NIDEK AFC-230 fundus camera, CFP
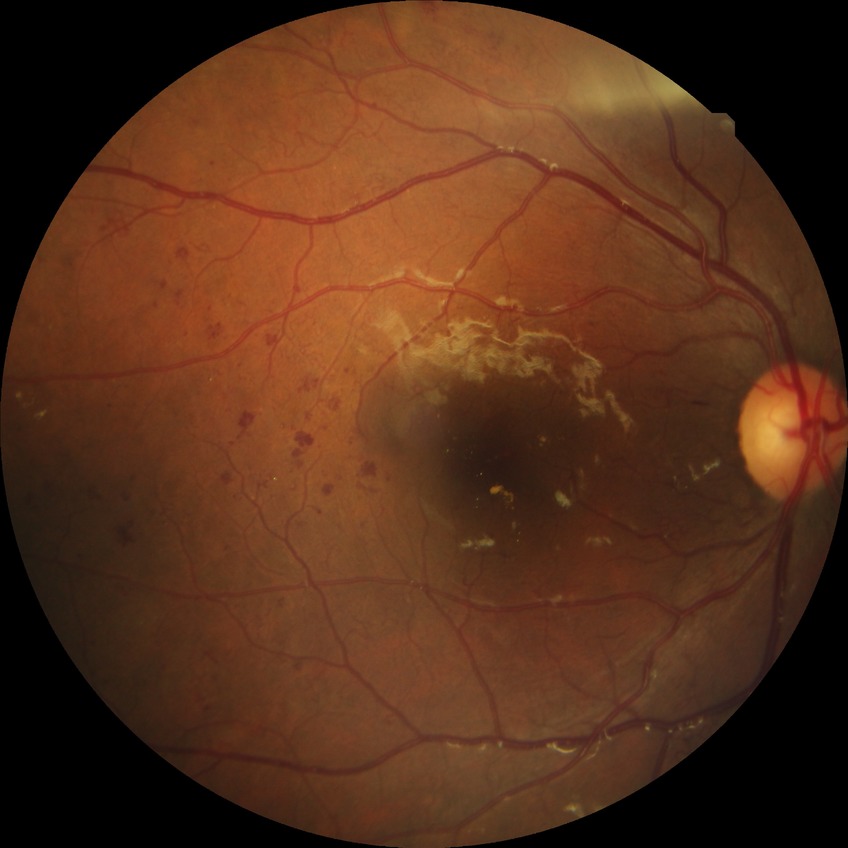

Diabetic retinopathy (DR): proliferative diabetic retinopathy (PDR).